2346x1568px:
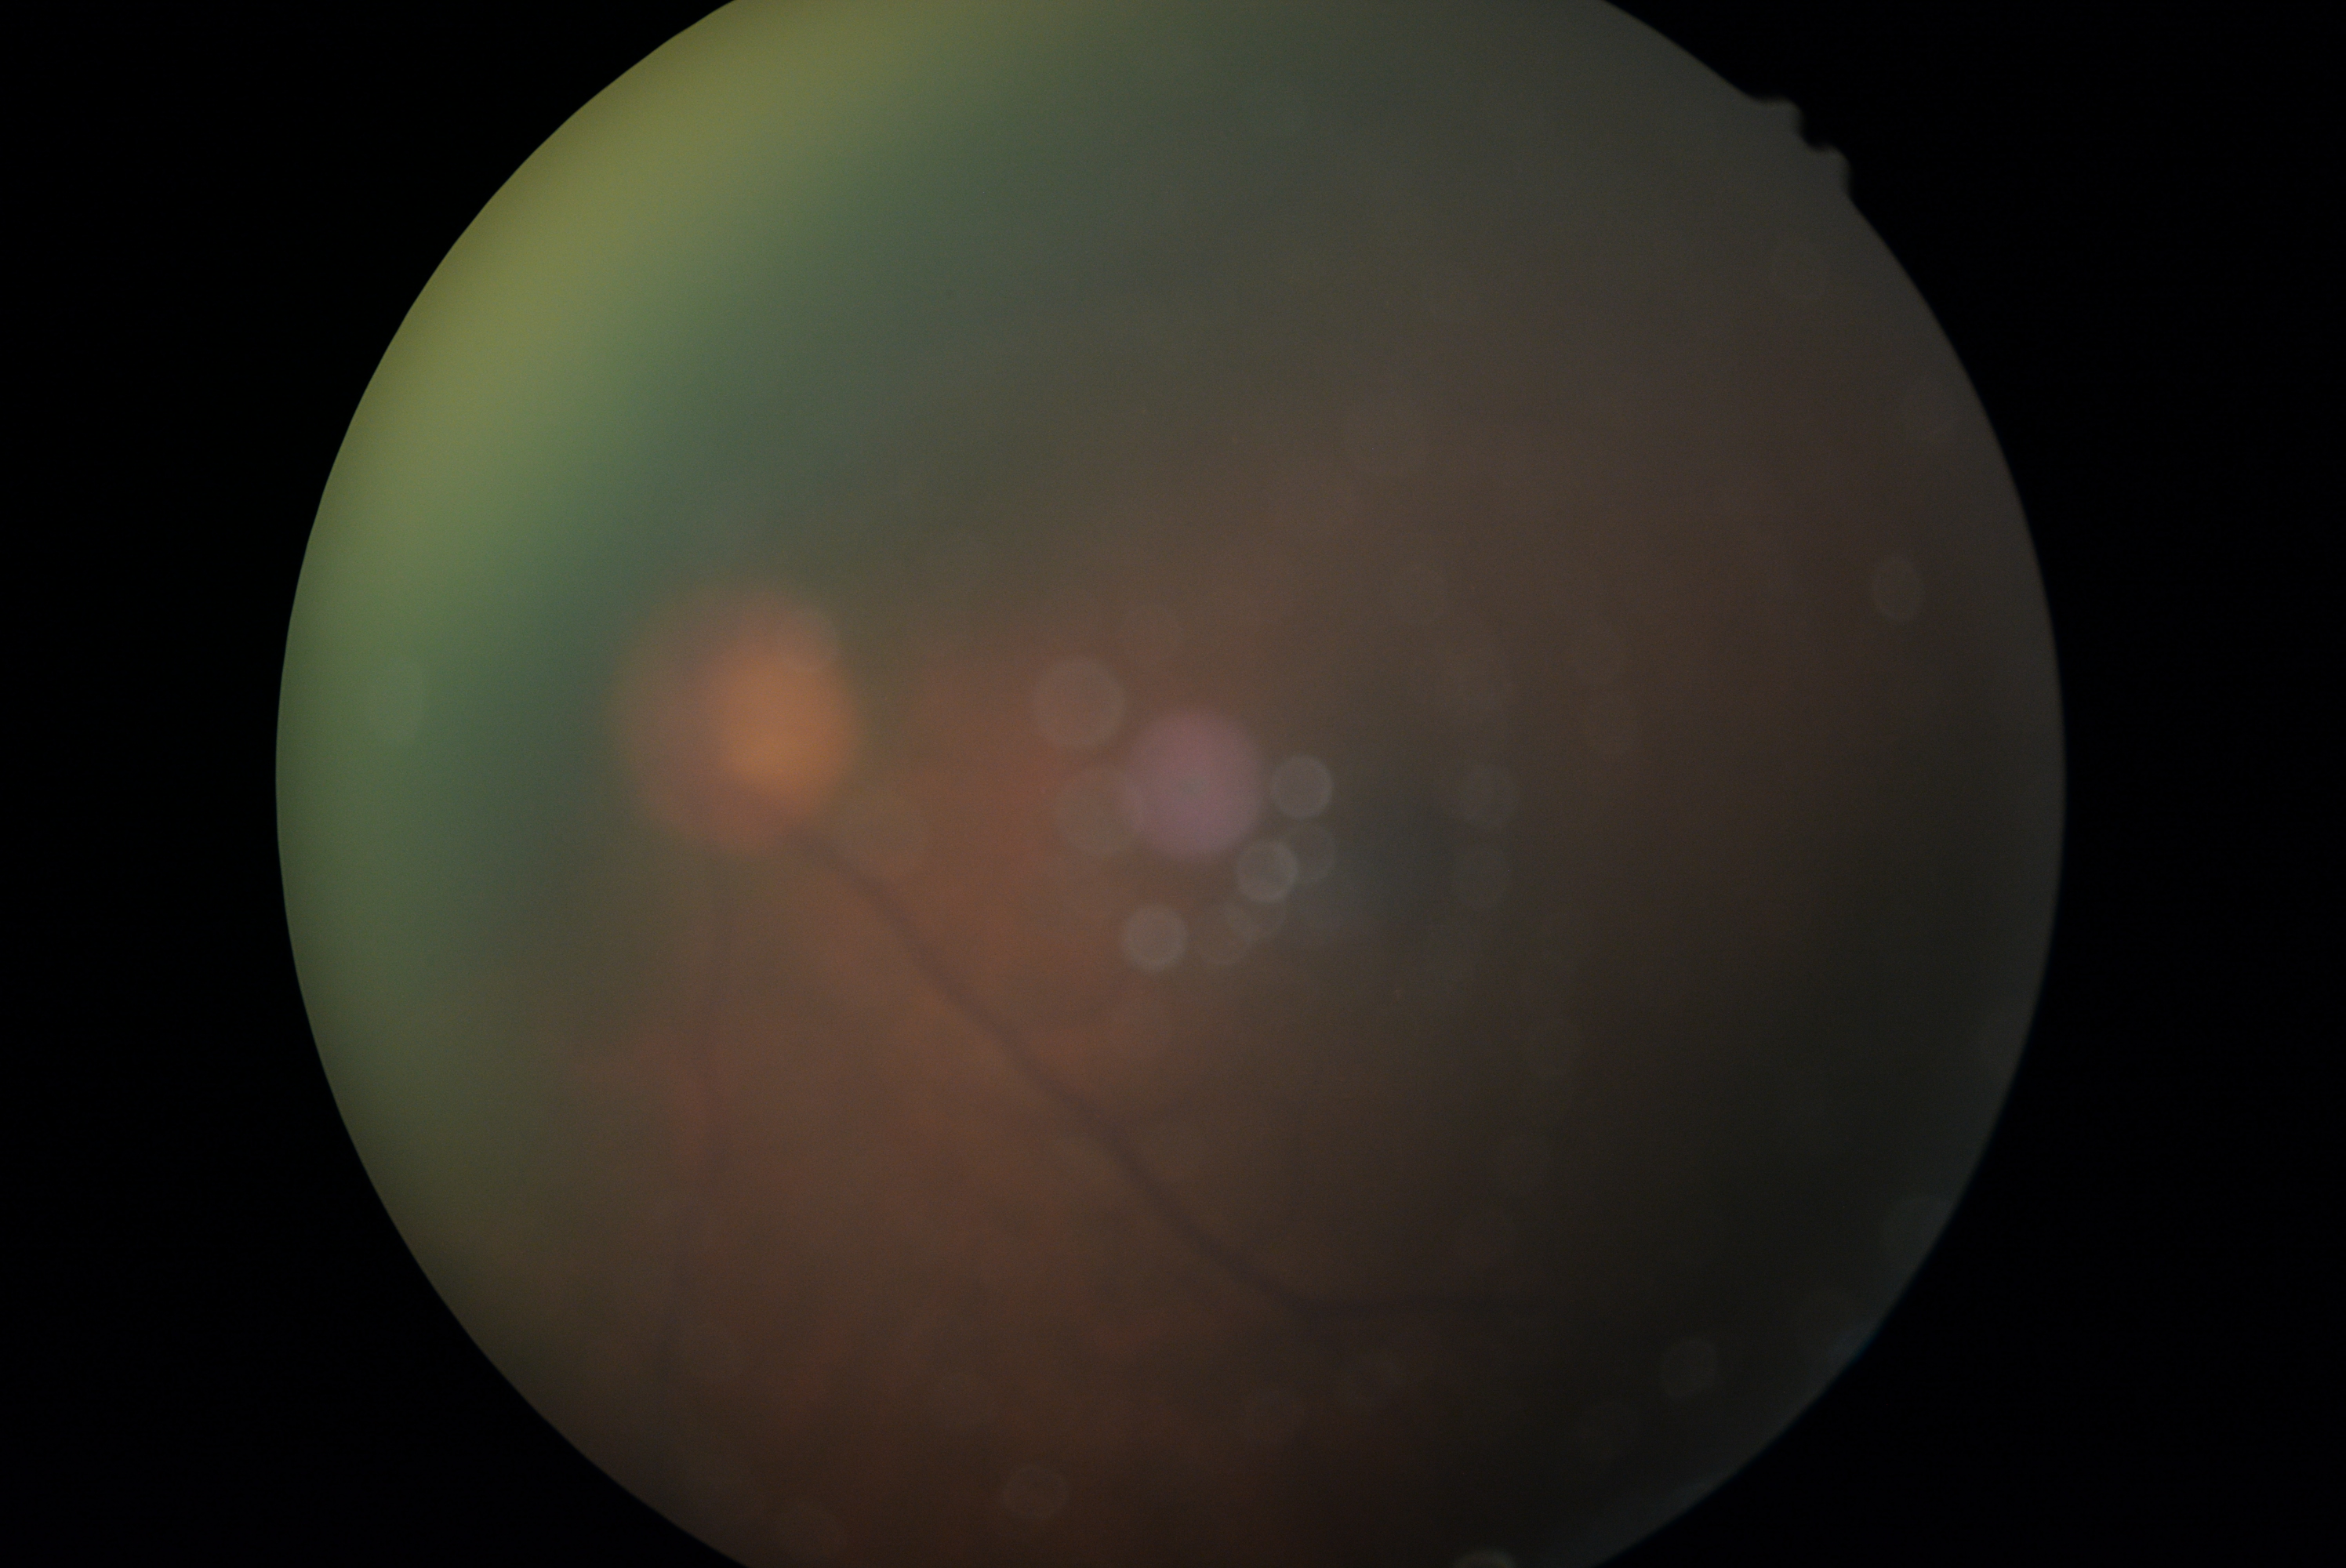

Quality too poor to assess for DR. DR grade: ungradable.